45-degree field of view:
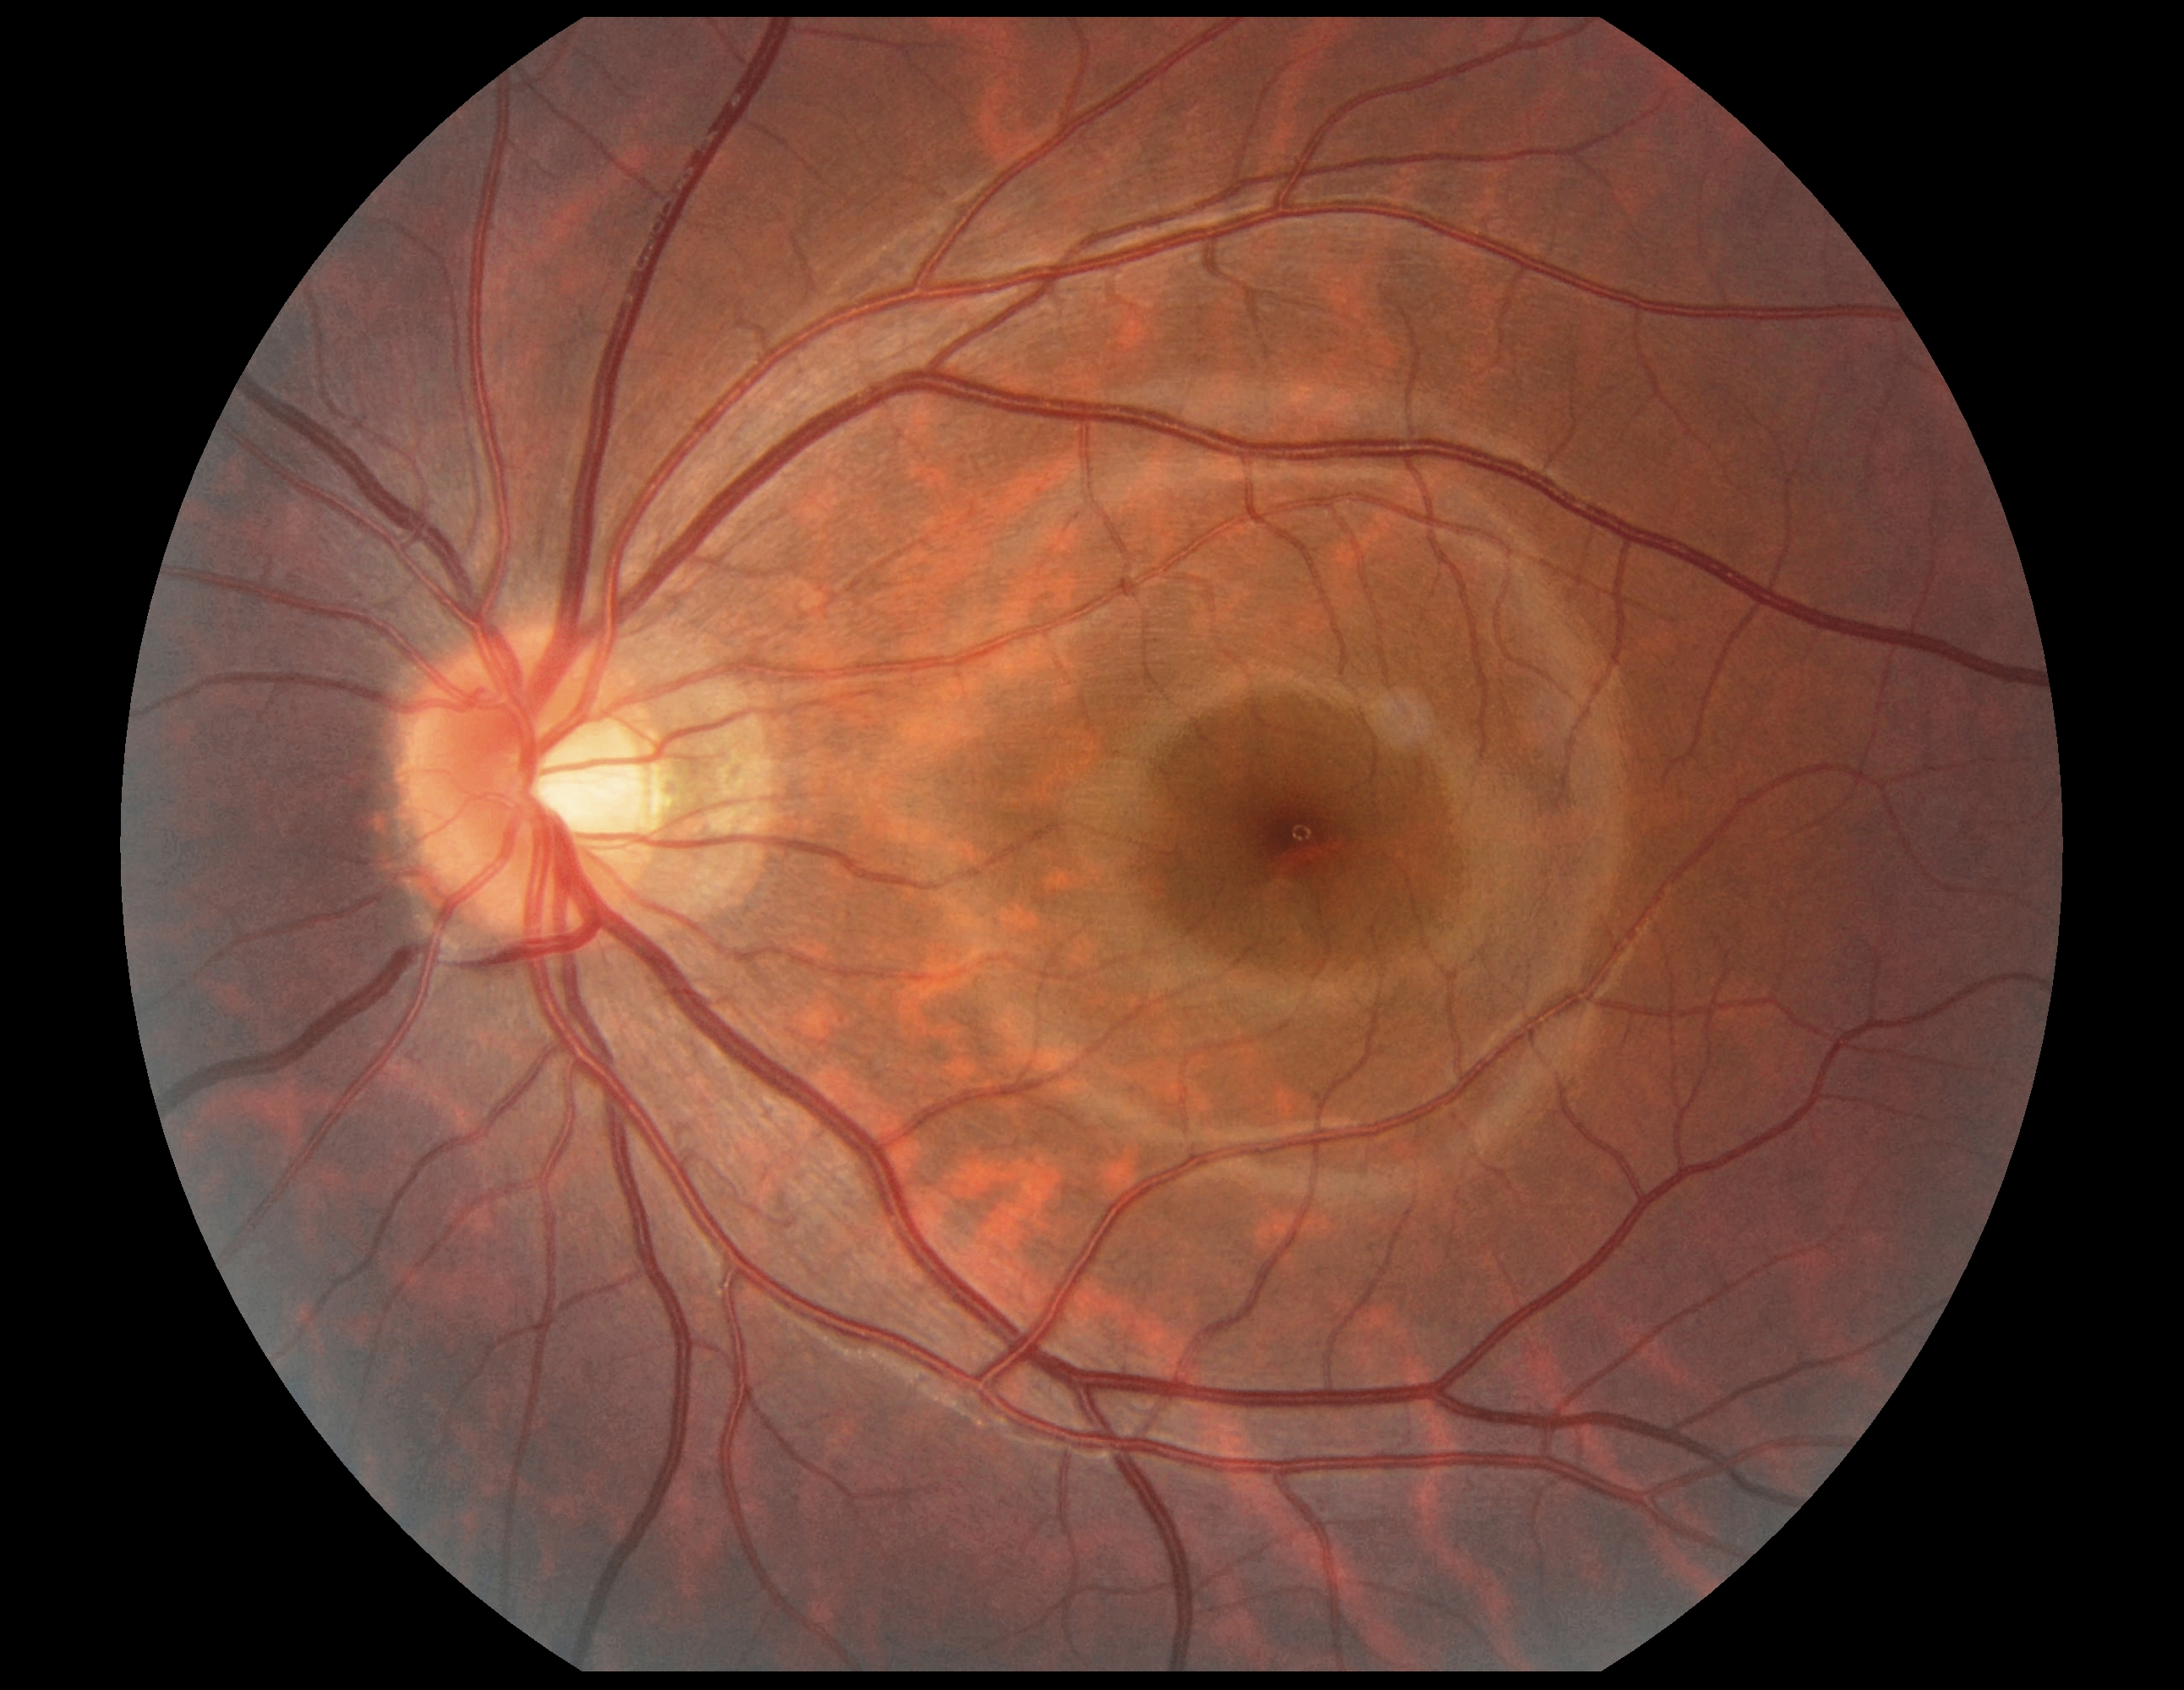 {
  "dr_grade": "0"
}